45° FOV. Color fundus image. 848 by 848 pixels. Graded on the modified Davis scale. Nonmydriatic fundus photograph.
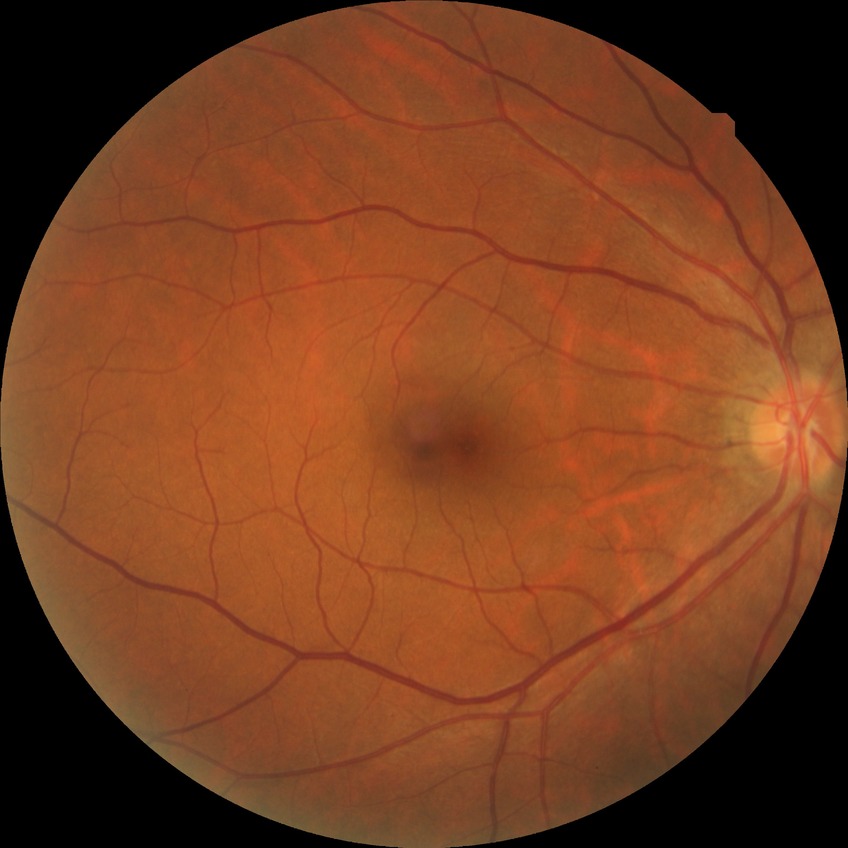
Diabetic retinopathy severity is no diabetic retinopathy.